CFP
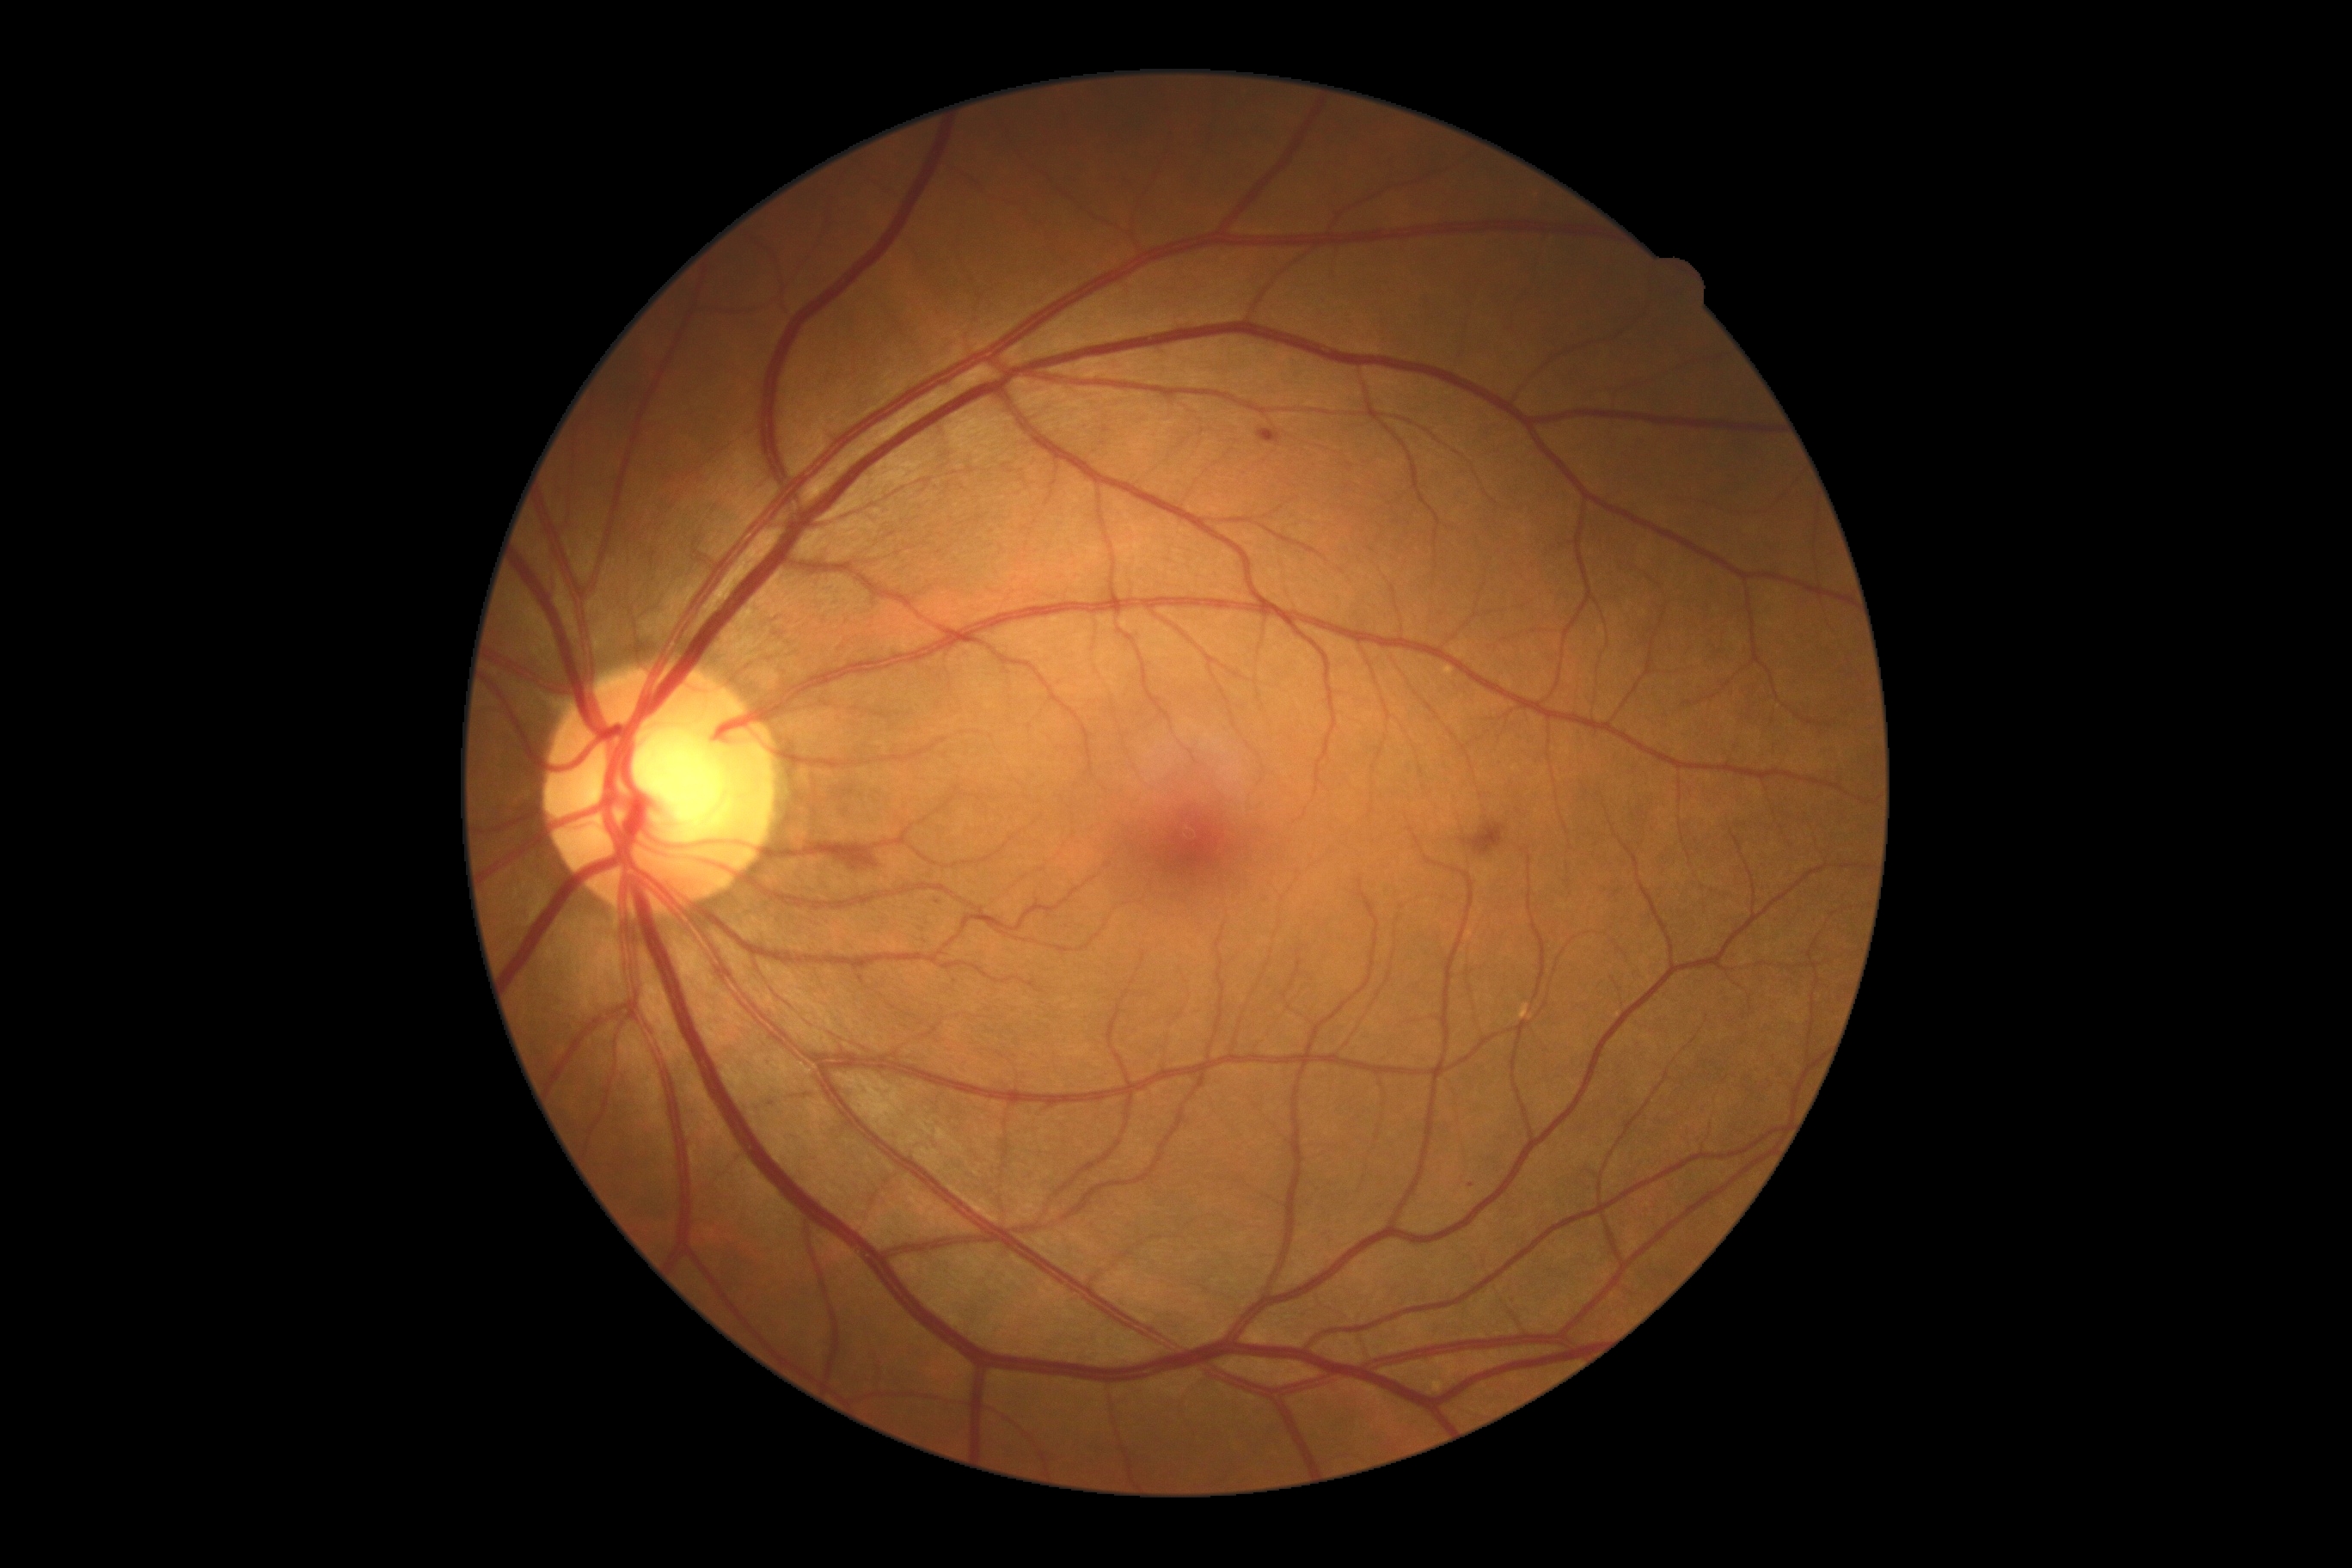
partial: true
dr_grade: 2
dr_grade_name: moderate NPDR
lesions:
  ex: []
  he:
    - <box>1462,823,1507,857</box>
    - <box>826,847,895,874</box>
    - <box>1258,429,1282,446</box>
    - <box>934,900,943,909</box>
  ma: []
  se: []